Non-mydriatic acquisition. Nidek AFC-330. Optic nerve head crop
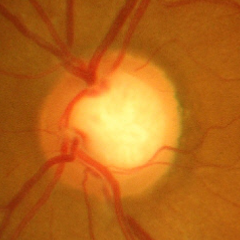
Glaucomatous changes are present. Demonstrates severe glaucomatous damage.